Wide-field contact fundus photograph of an infant · Clarity RetCam 3, 130° FOV · 640x480px:
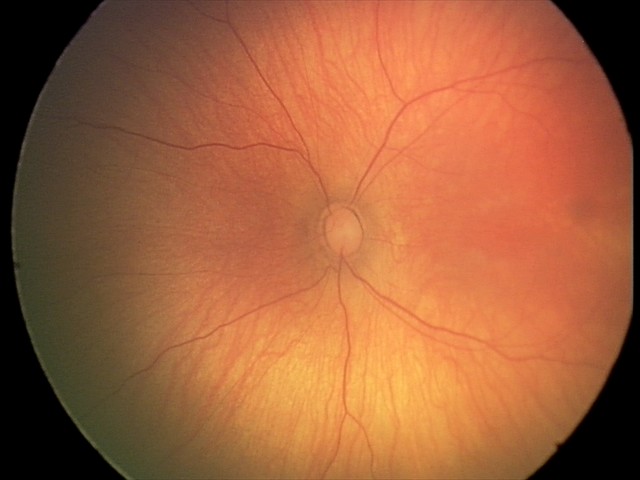
Impression: physiological retinal finding.